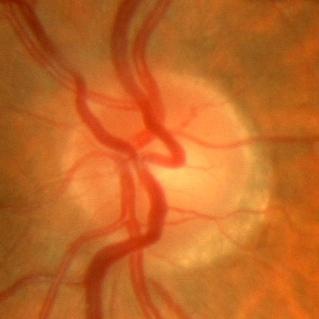 Optic nerve head appearance consistent with no glaucoma.